CFP
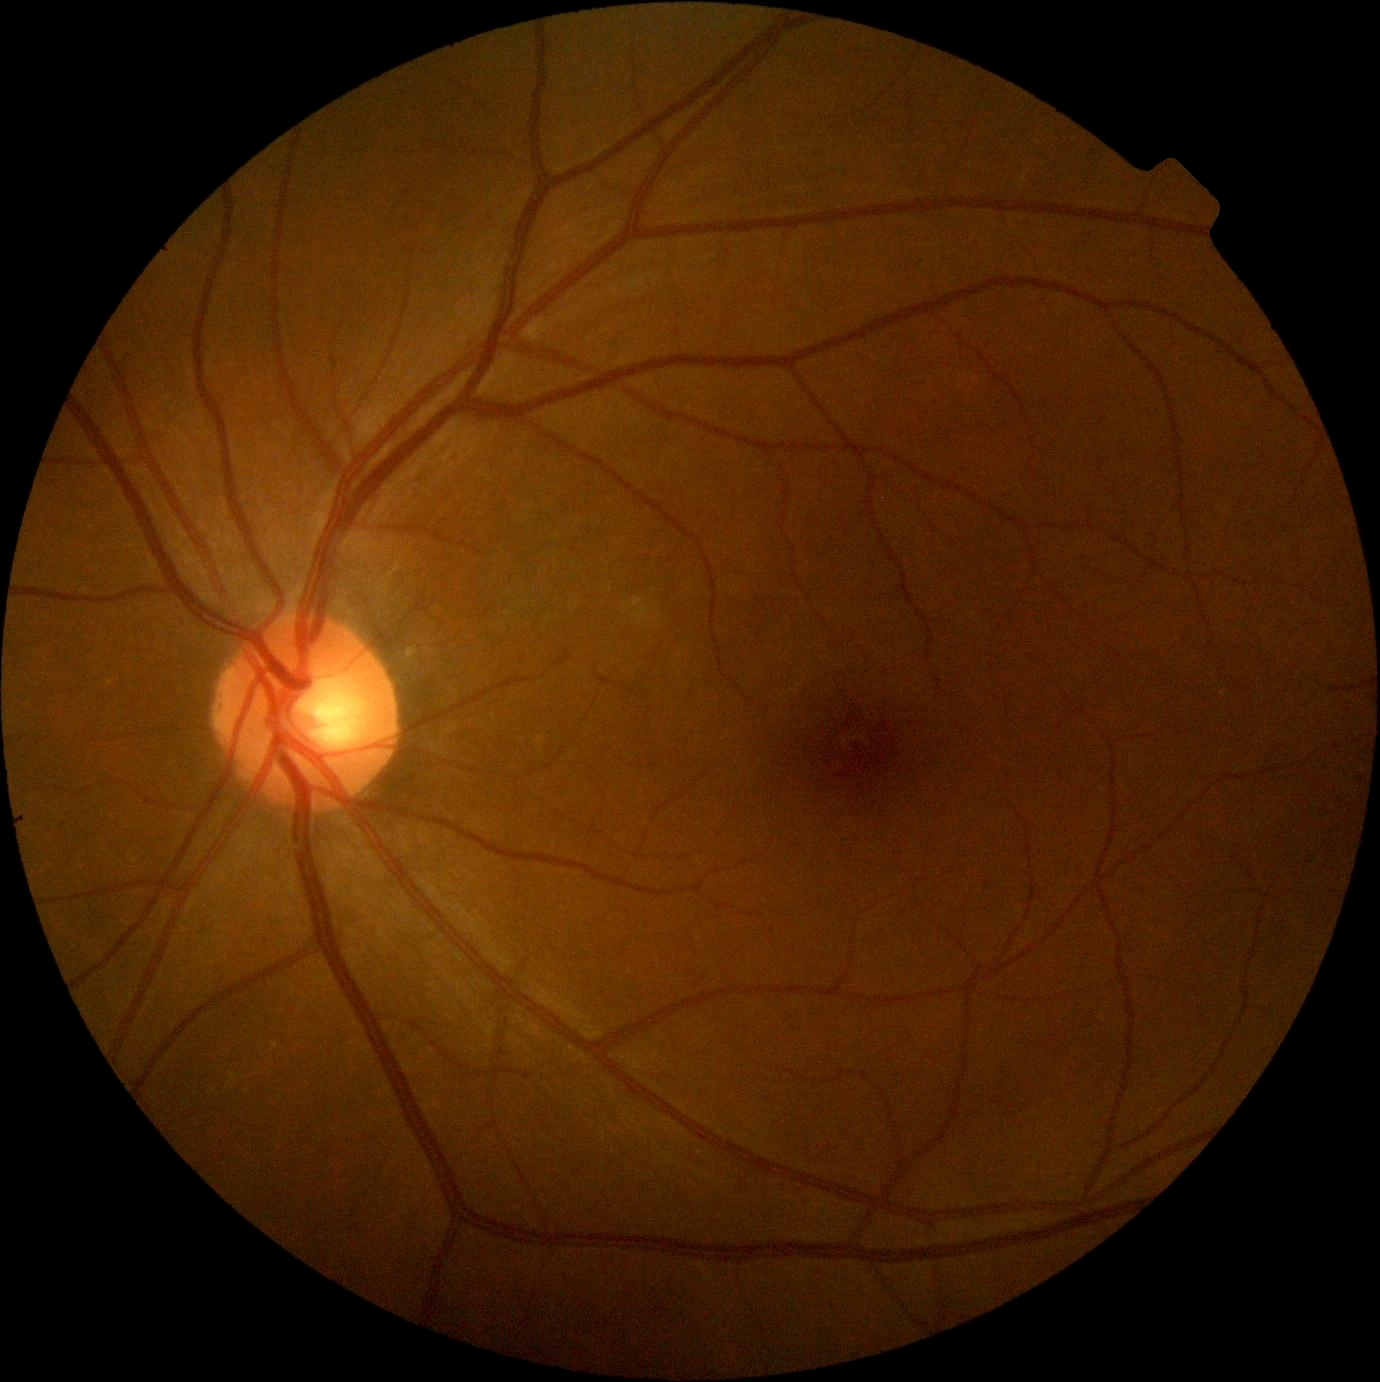 Annotations:
- diabetic retinopathy severity: 0/4